848x848px, modified Davis classification, CFP: 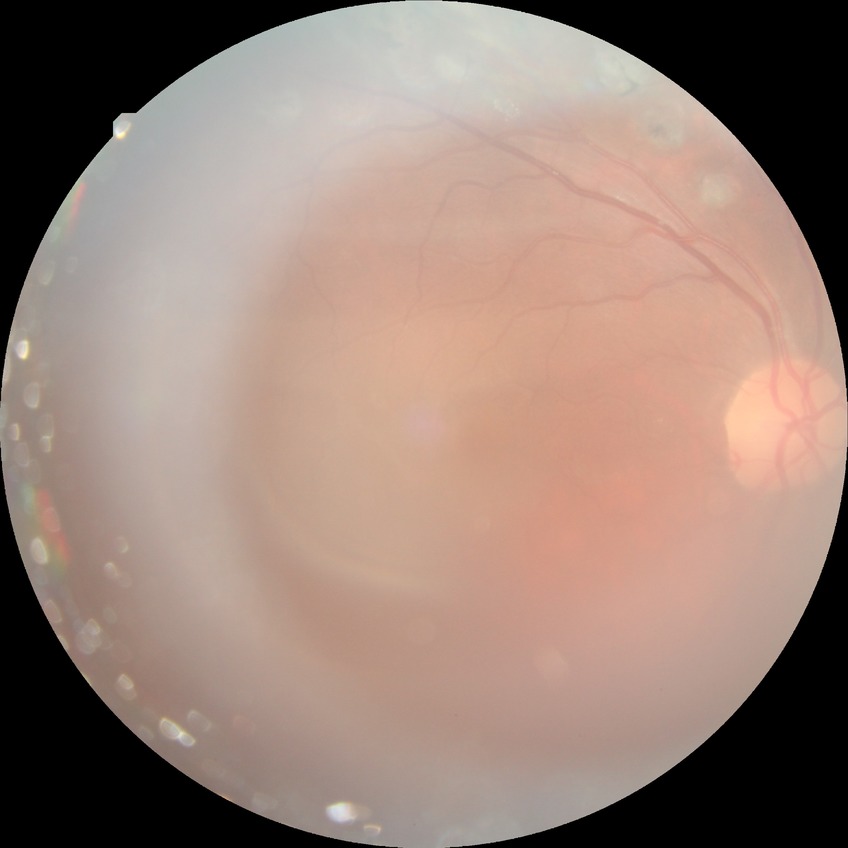 {
  "davis_grade": "PDR (proliferative diabetic retinopathy)"
}